Wide-field fundus photograph from neonatal ROP screening; Clarity RetCam 3, 130° FOV: 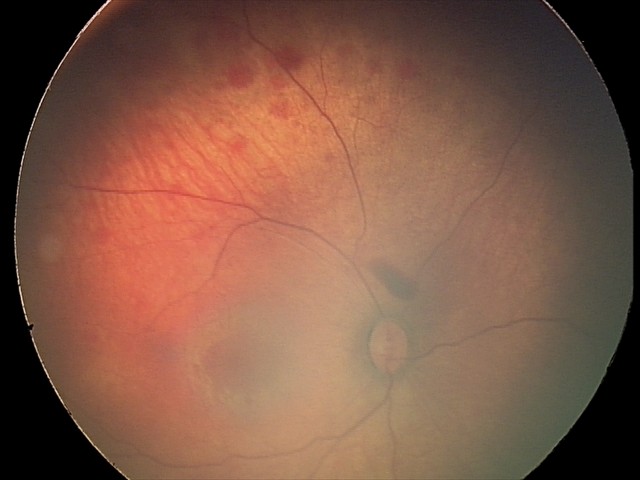
Assessment: retinal hemorrhages.